Tabletop color fundus camera image
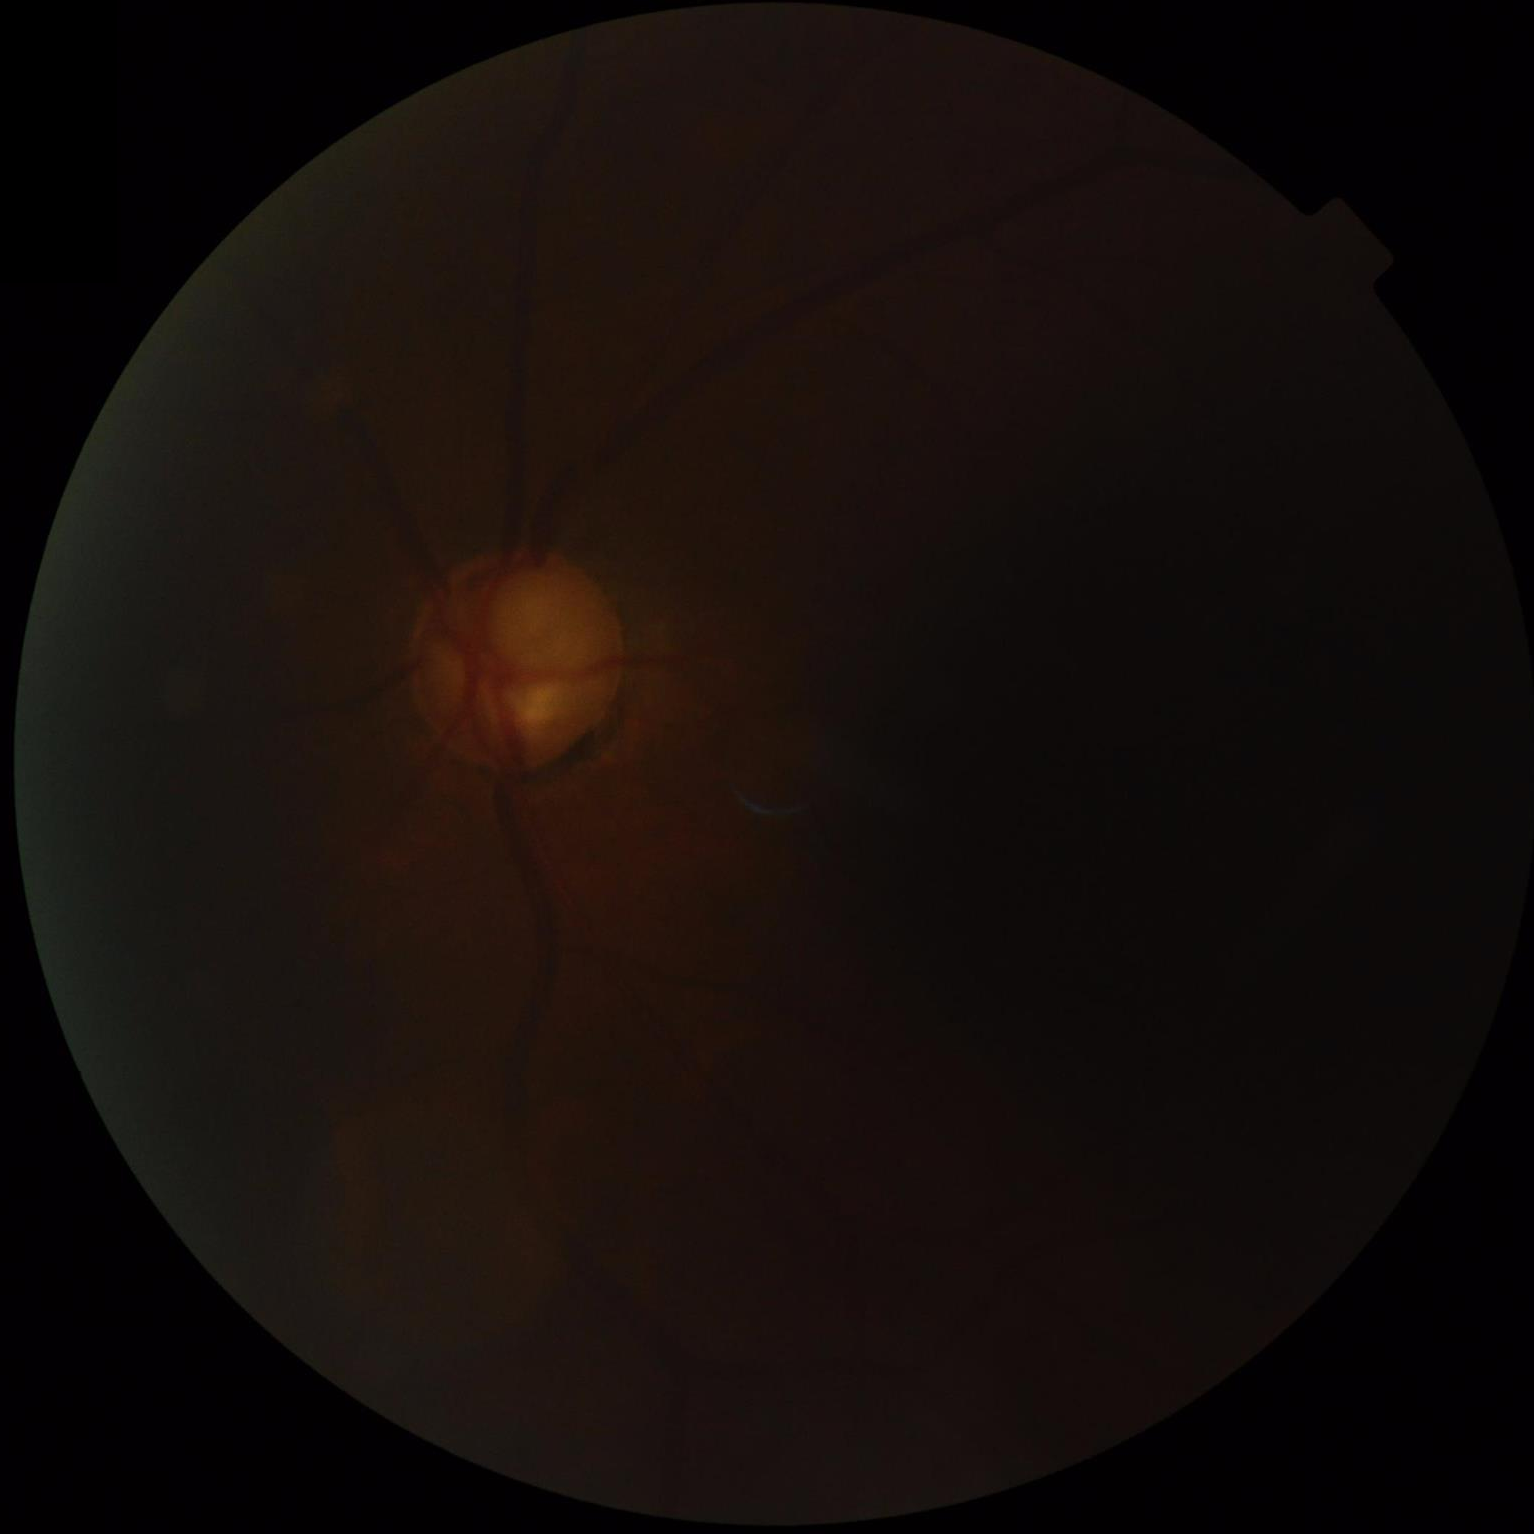

Quality grading:
- contrast: narrow intensity range, structures hard to distinguish
- overall: inadequate for clinical interpretation
- illumination/color: inadequate, with uneven exposure or color distortion
- clarity: reduced sharpness with visible blur